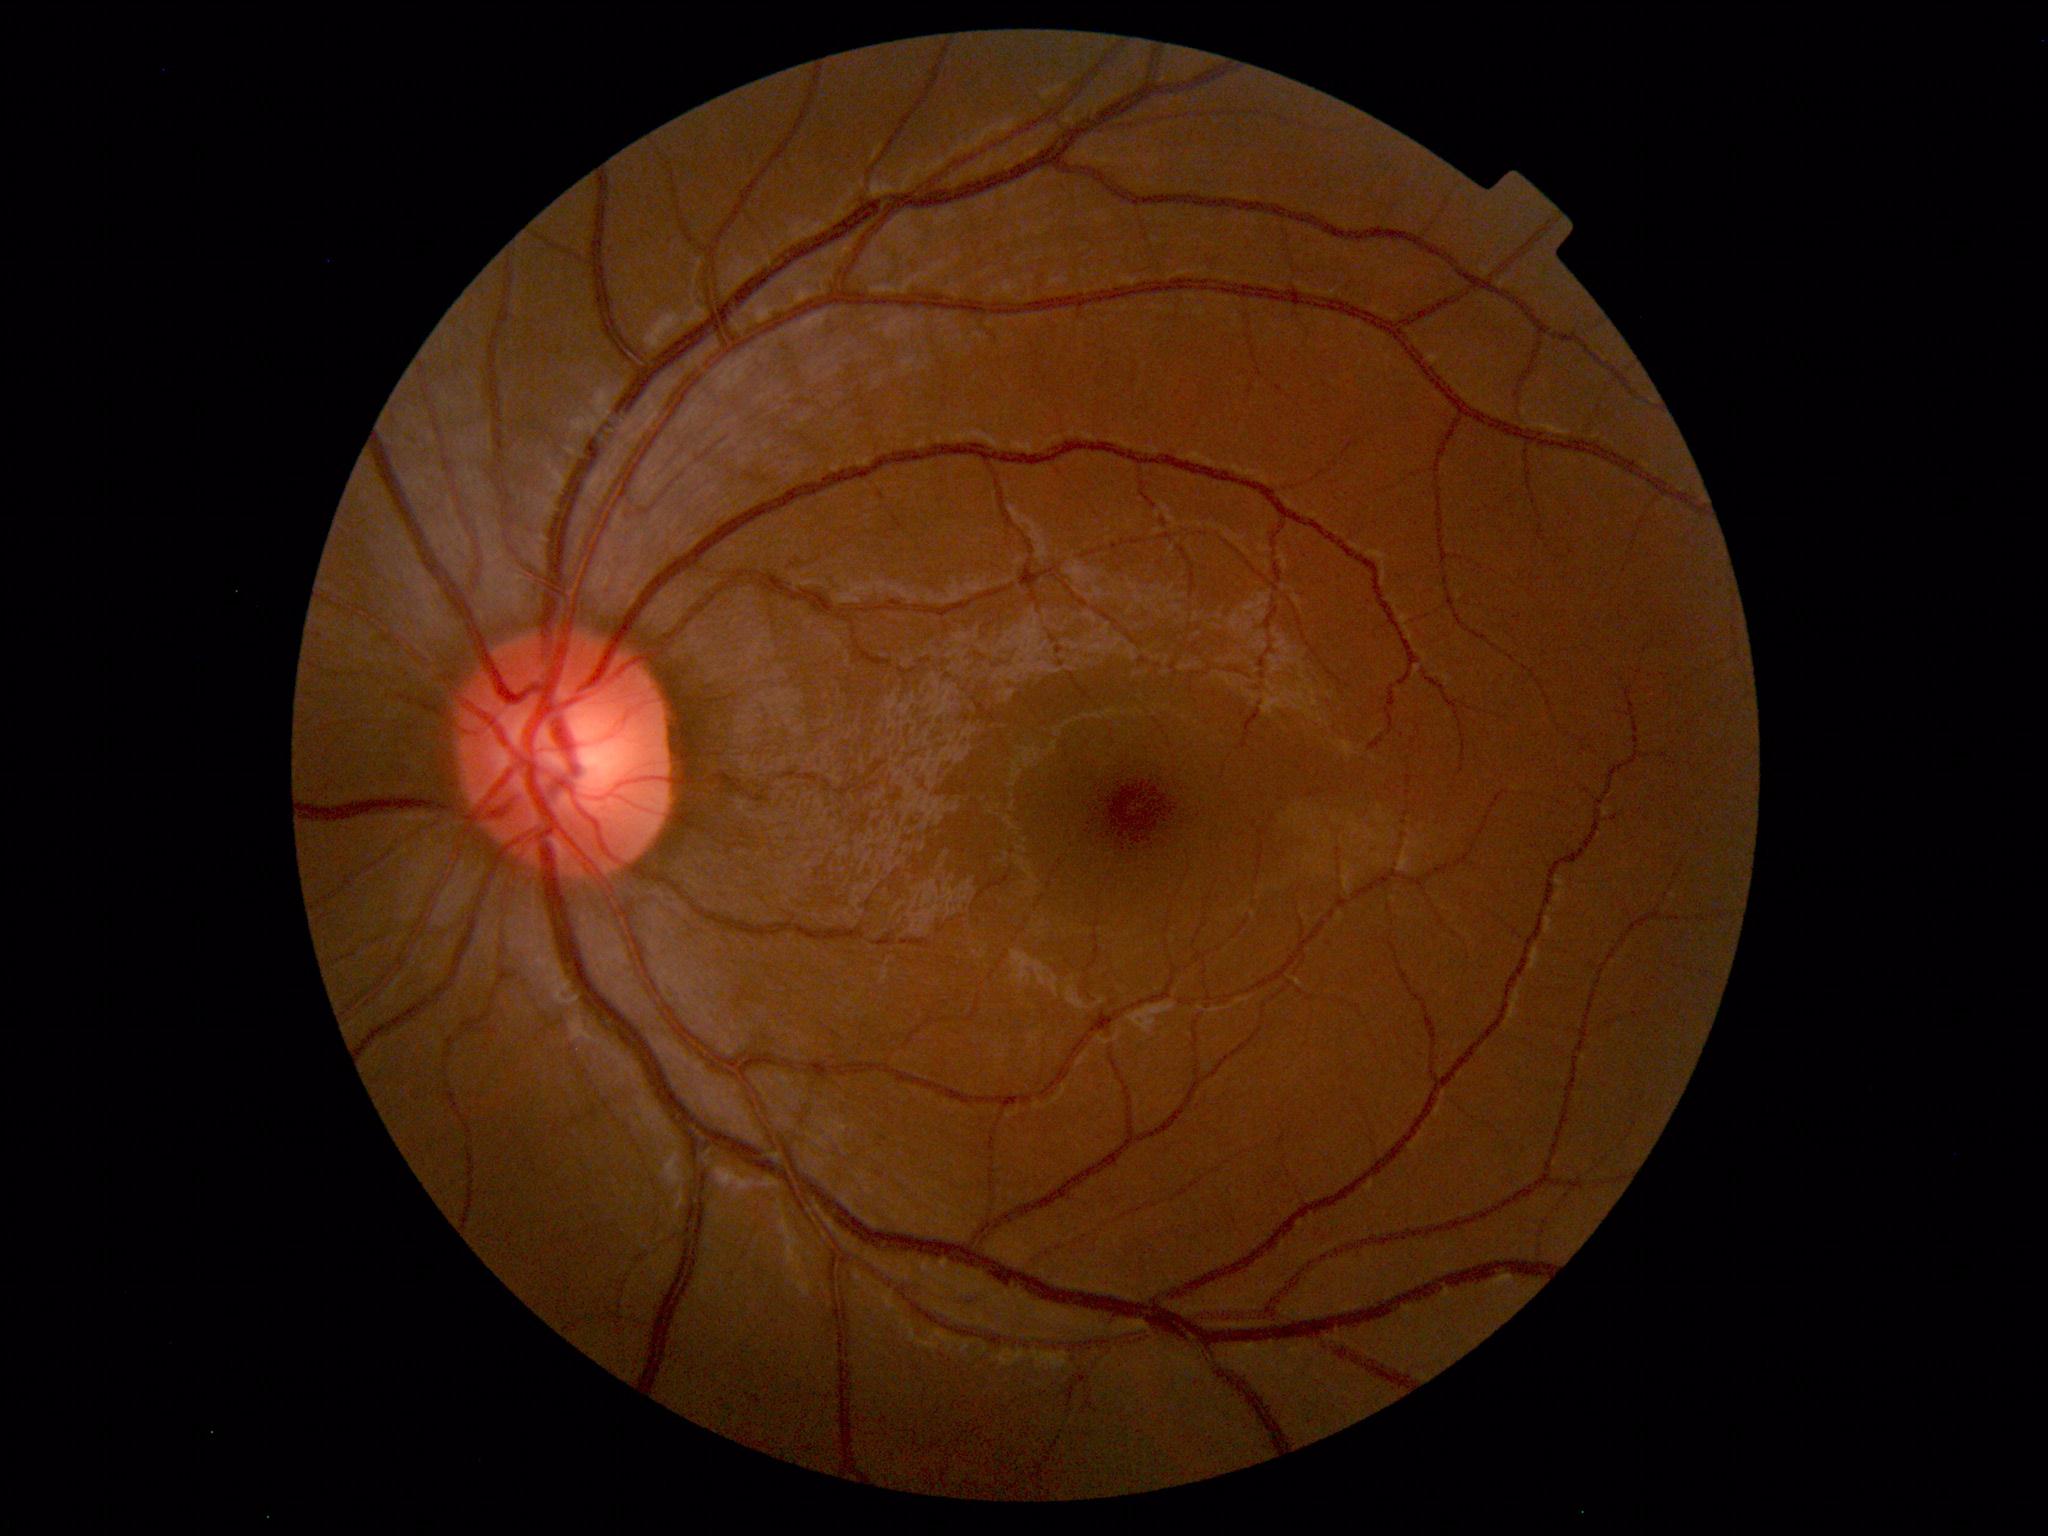 Fundus photograph within normal limits.